2352 x 1568 pixels · 45° field of view
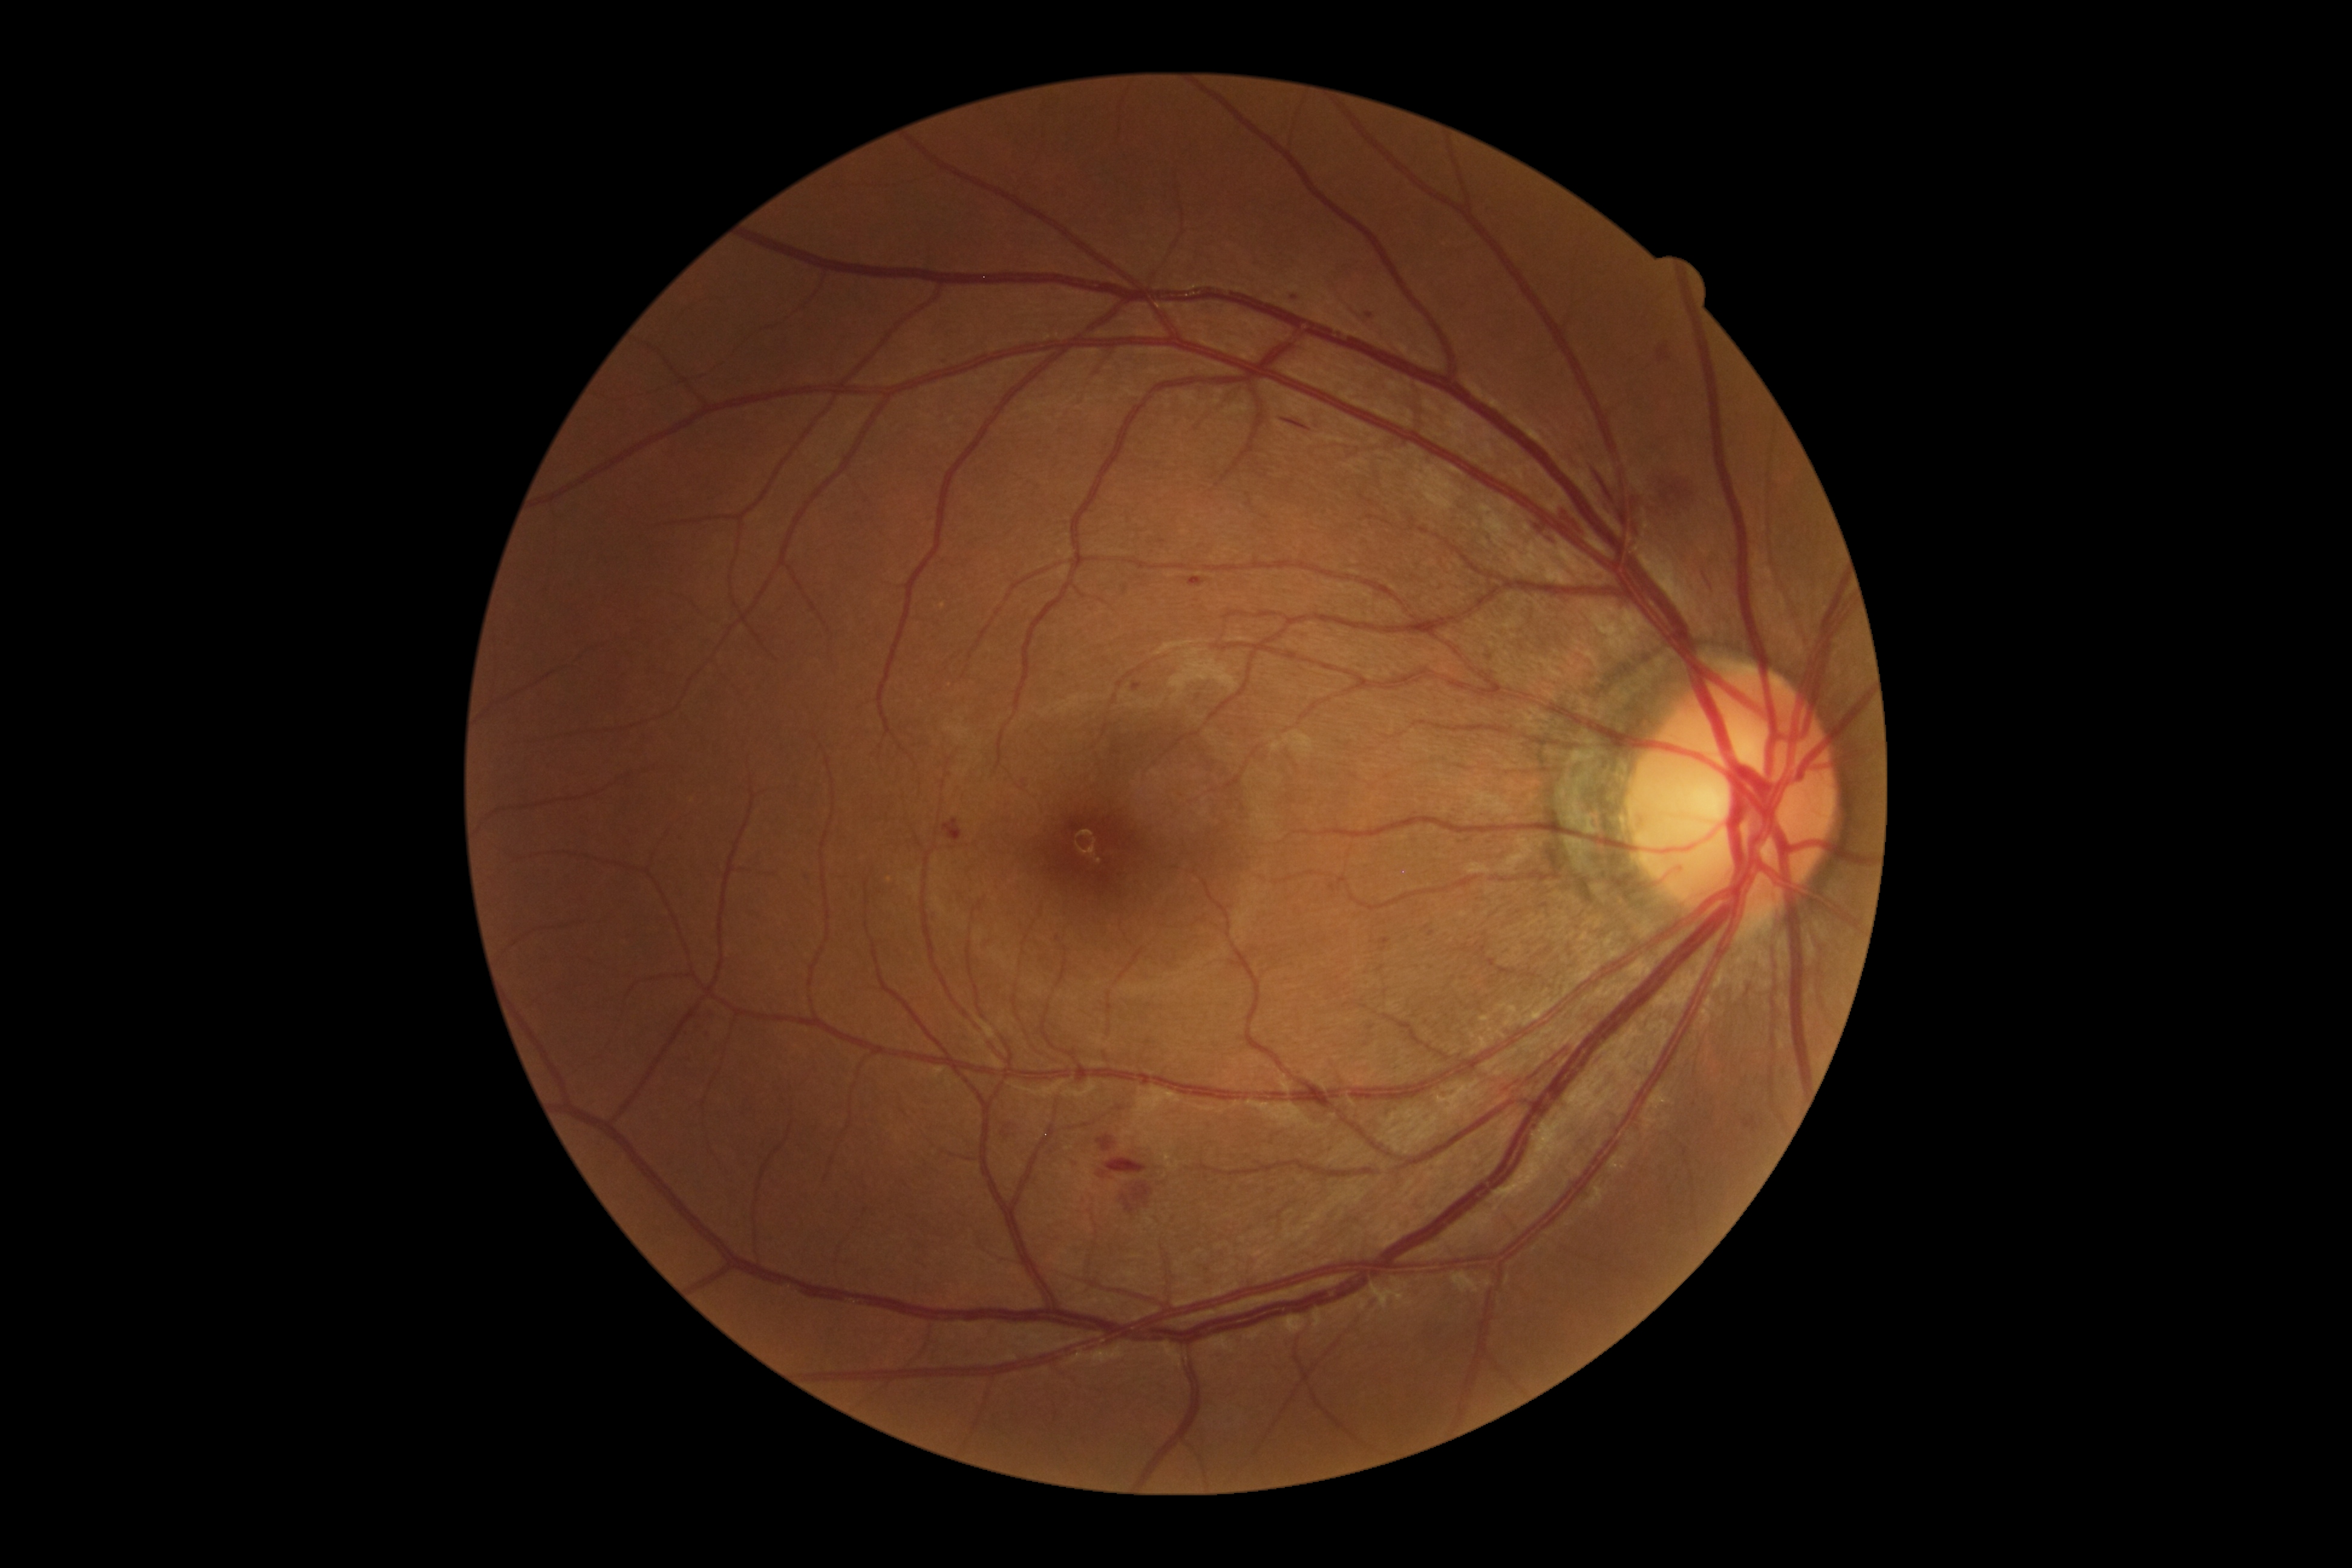
Diabetic retinopathy (DR): 2/4.